50° FOV
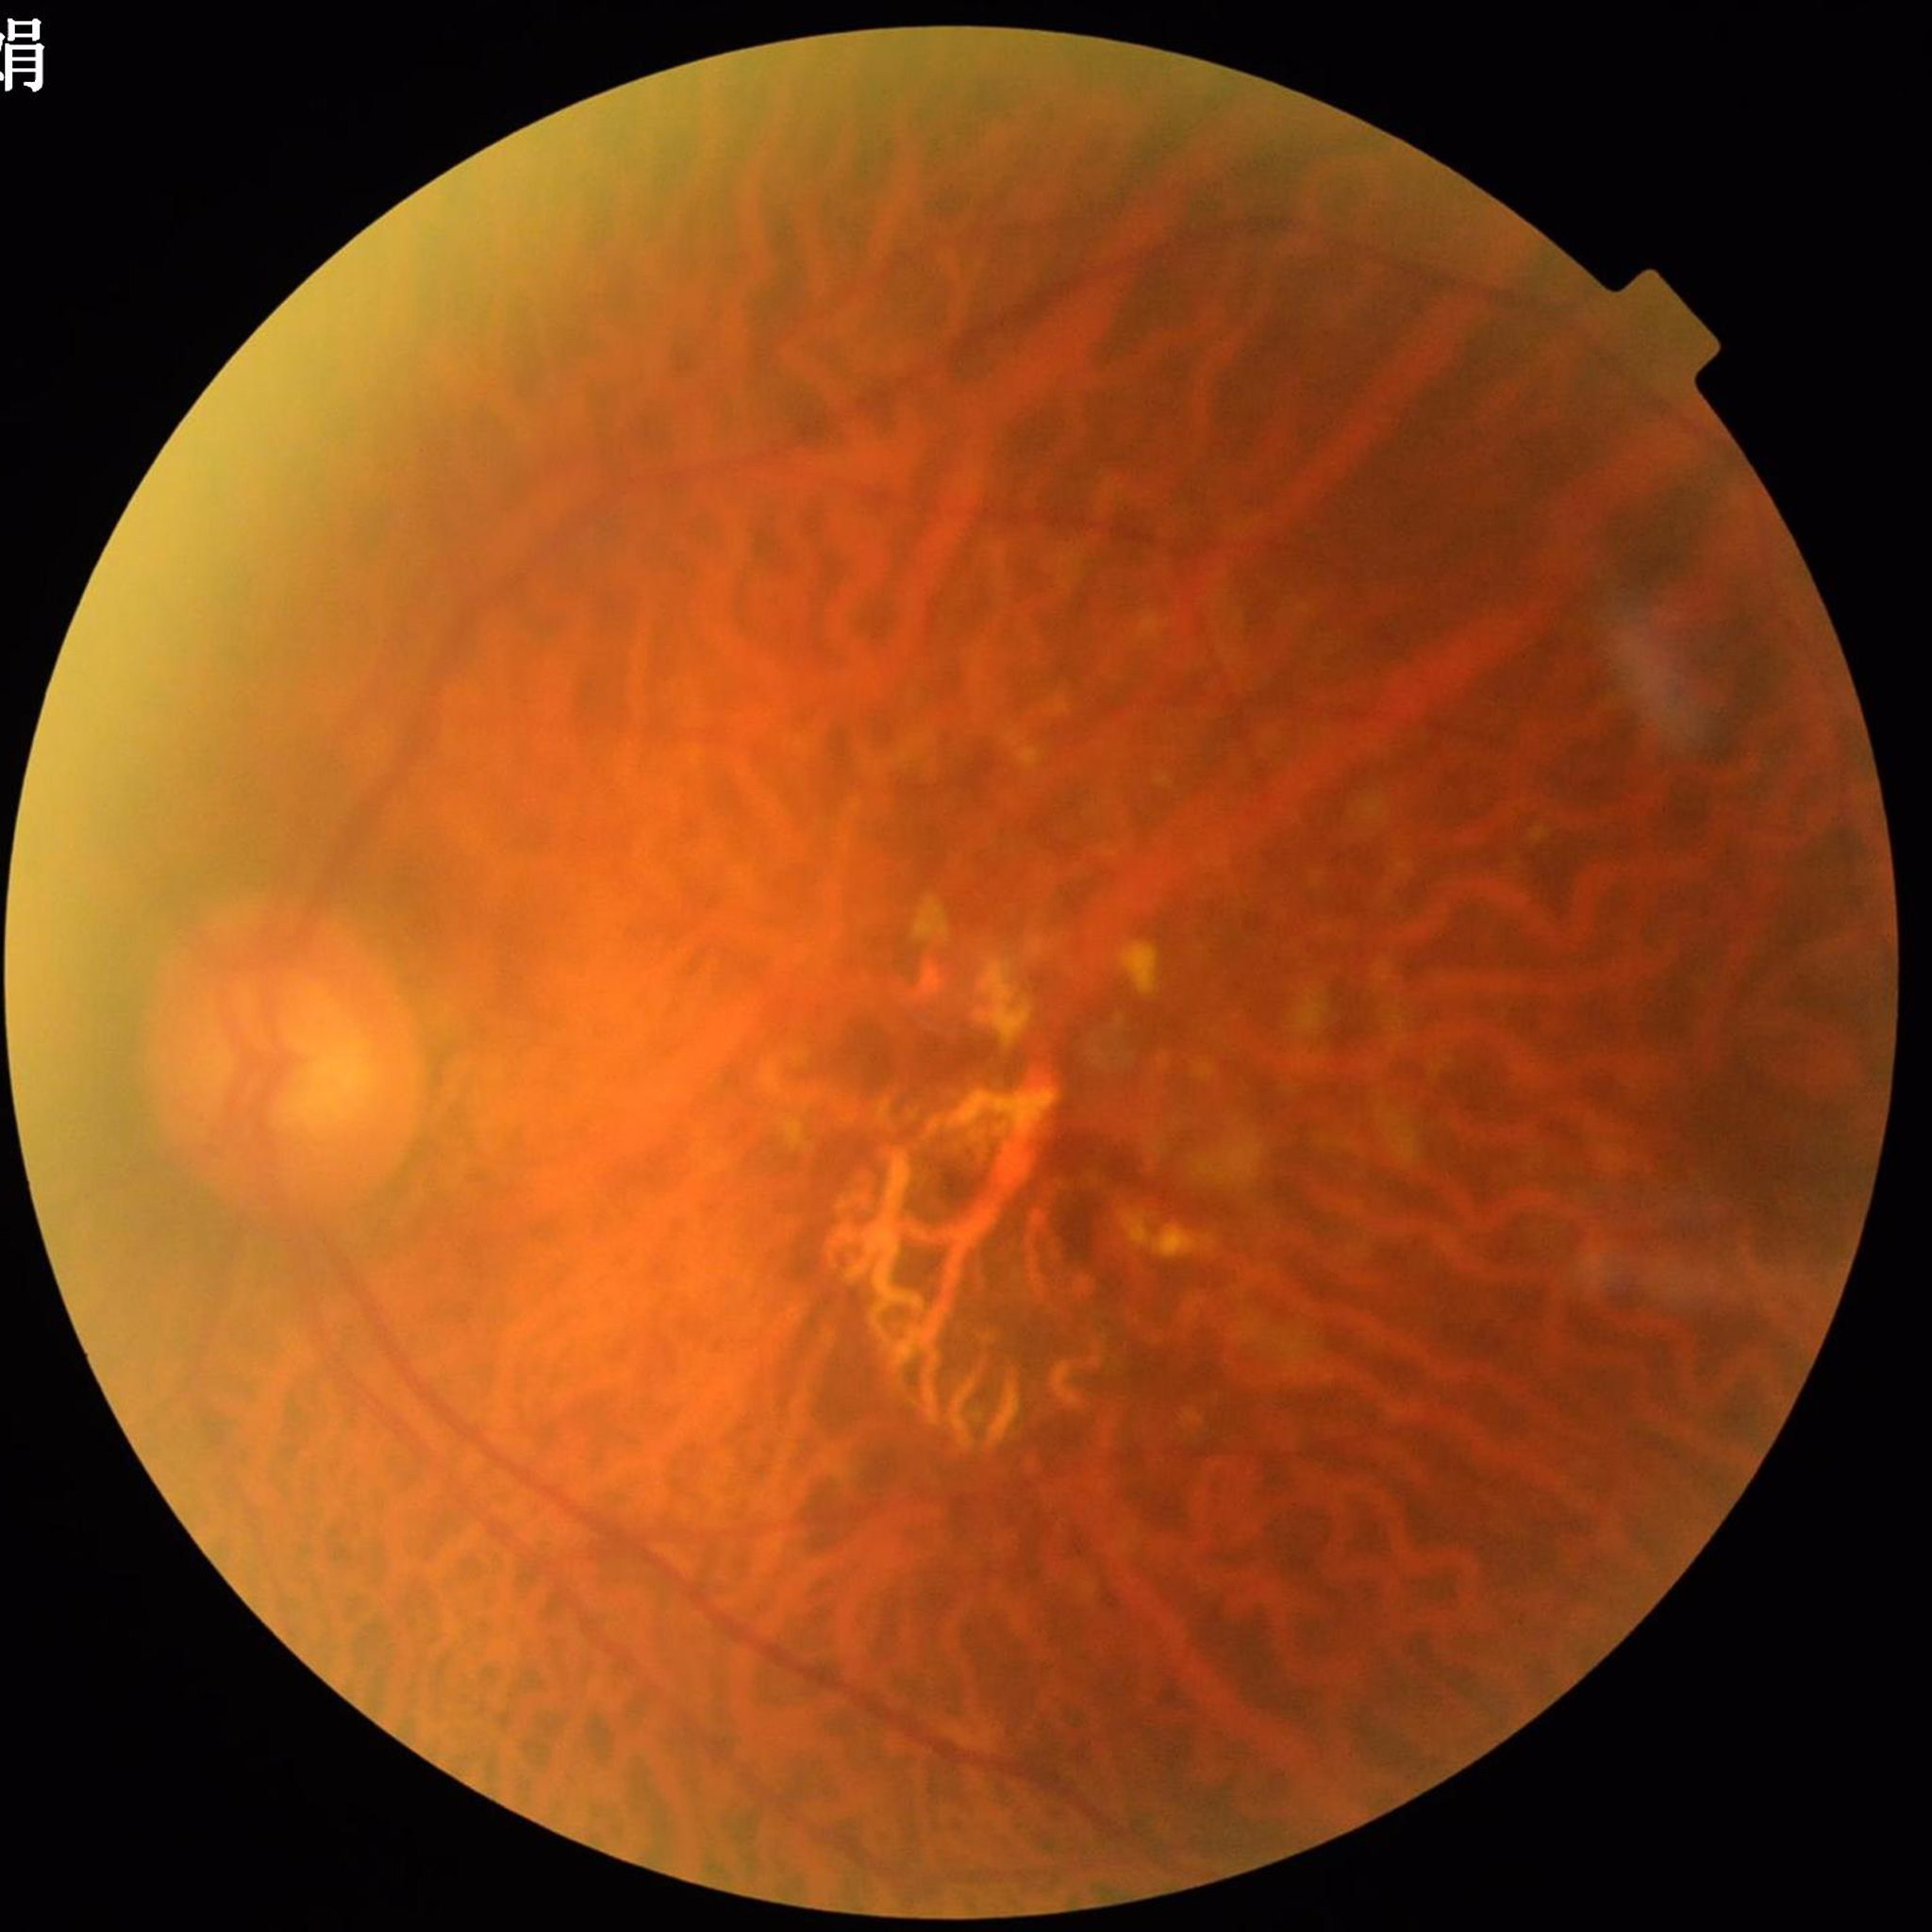

Patient diagnosed with age-related macular degeneration.
Photo quality: concerns include illumination/color distortion, blur.